Age 57; axial length: 24.4 mm; autorefraction: -0.25 -0.75 × 100°; sex: F; intraocular pressure (IOP) 11 mmHg by pneumatic tonometry; central corneal thickness 517 µm:
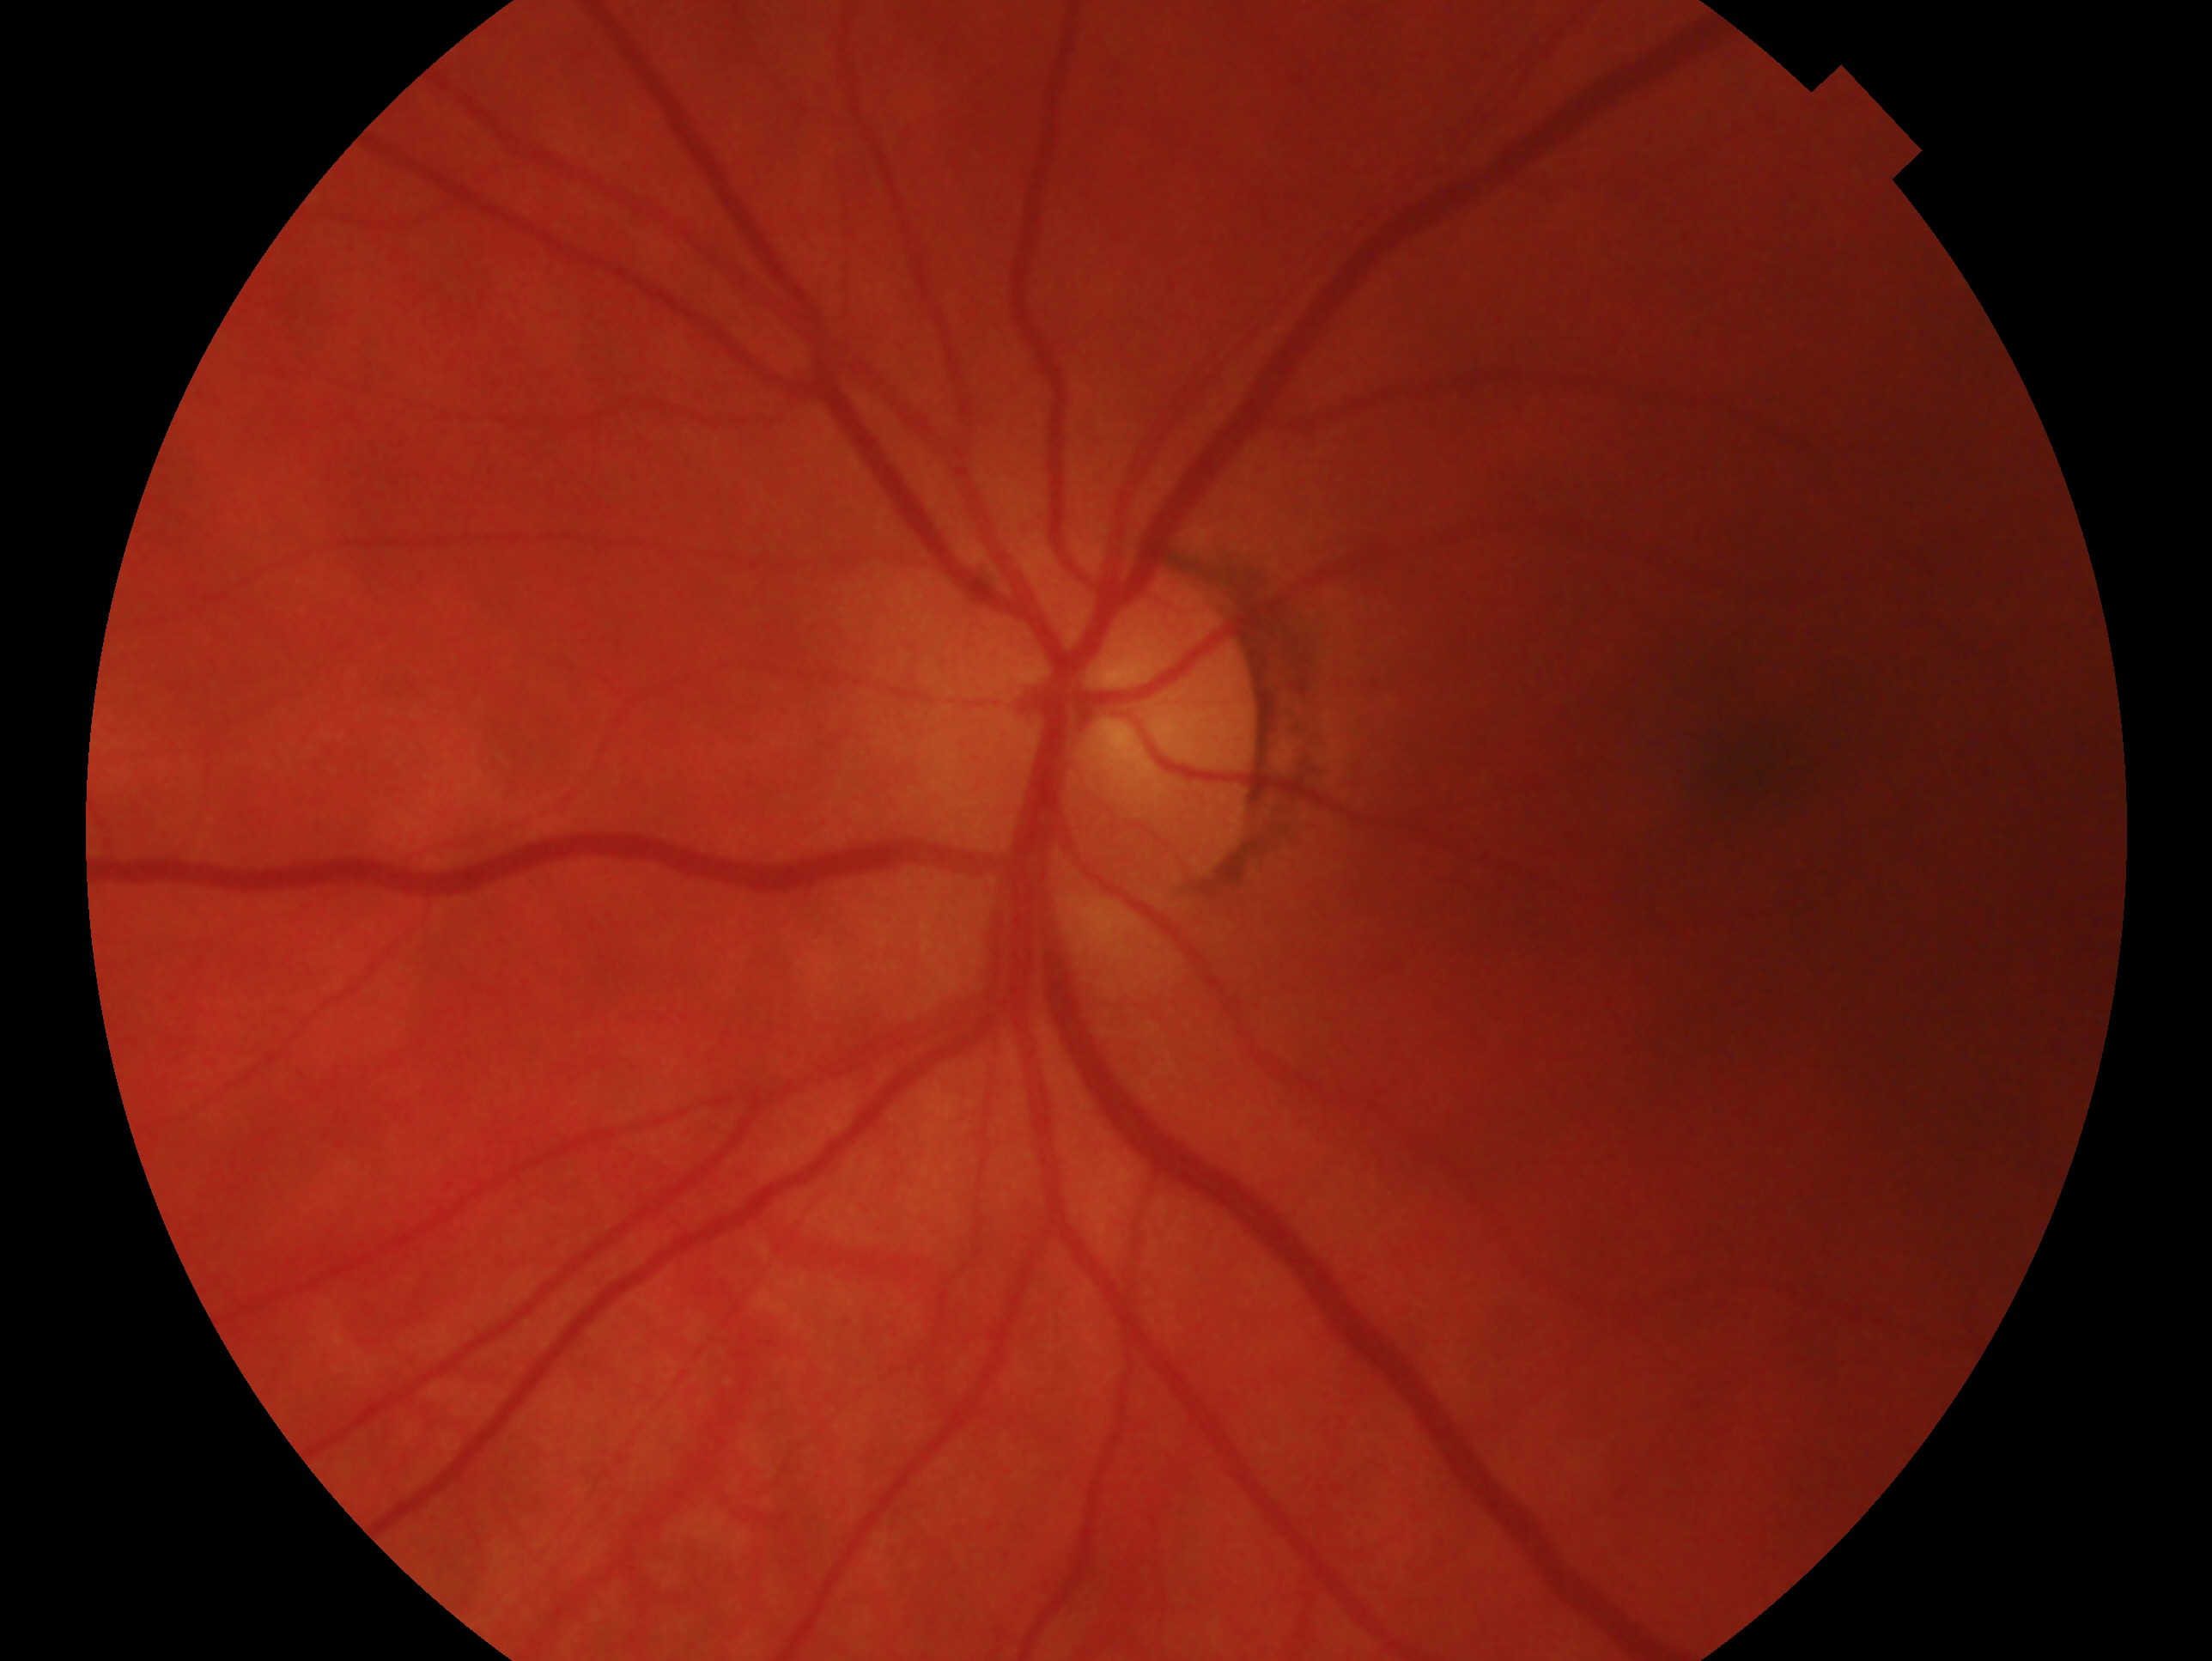

Impression: negative for glaucoma. Eye: oculus sinister.